Wide-field fundus image from infant ROP screening. Camera: Phoenix ICON (100° FOV) — 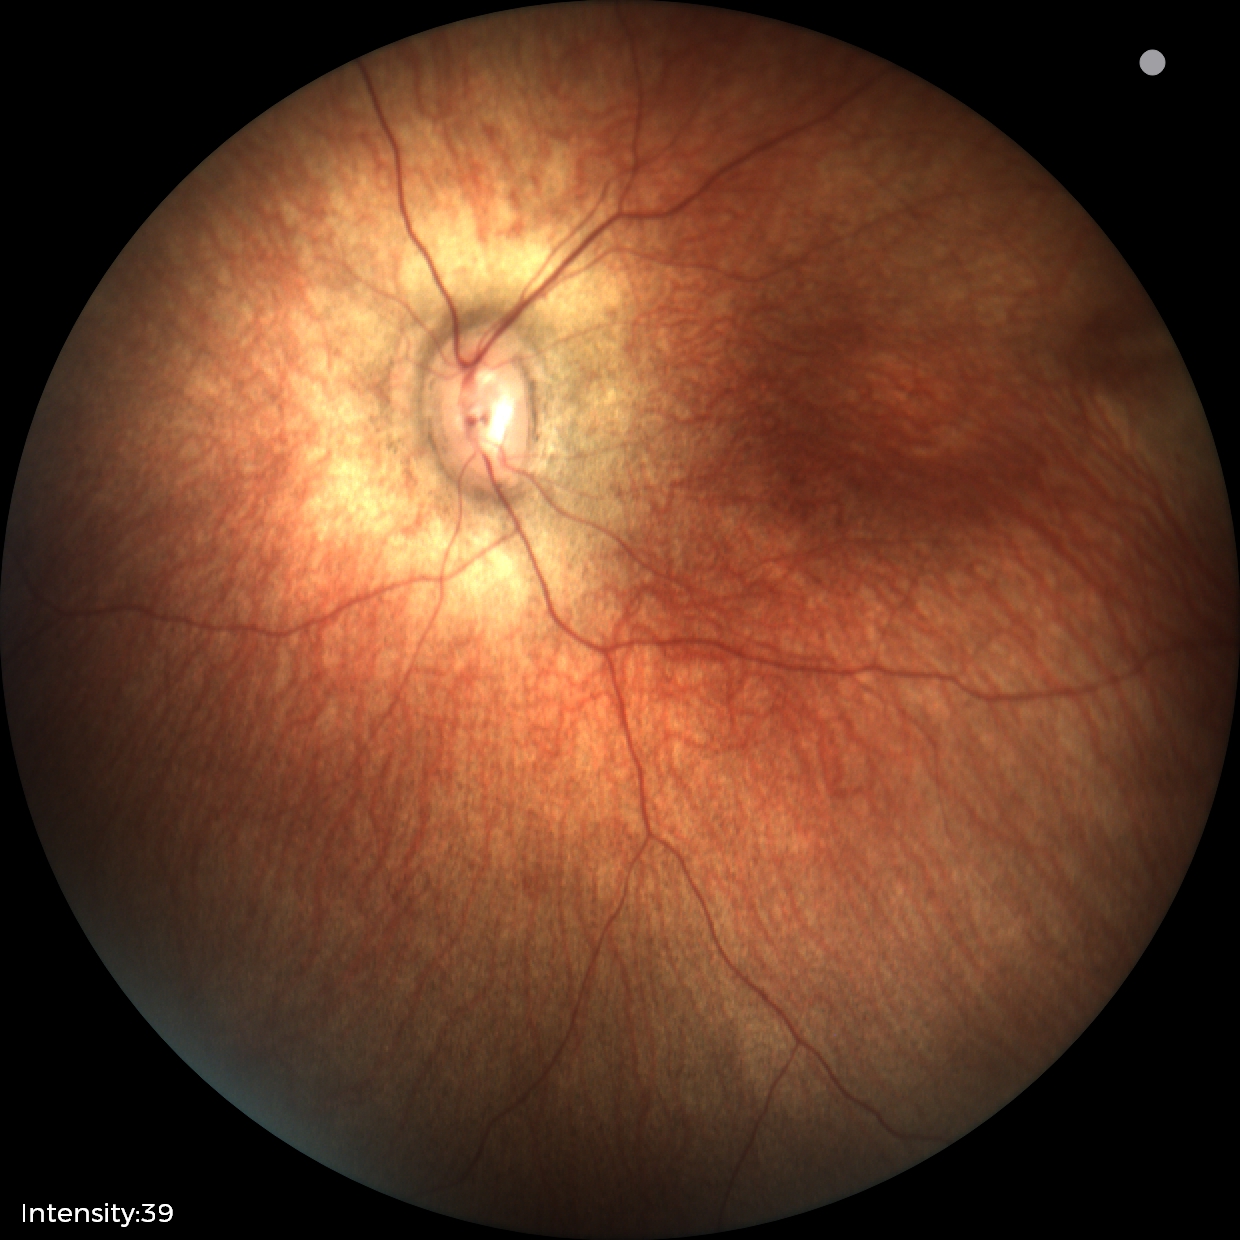
Assessment: normal retinal appearance.